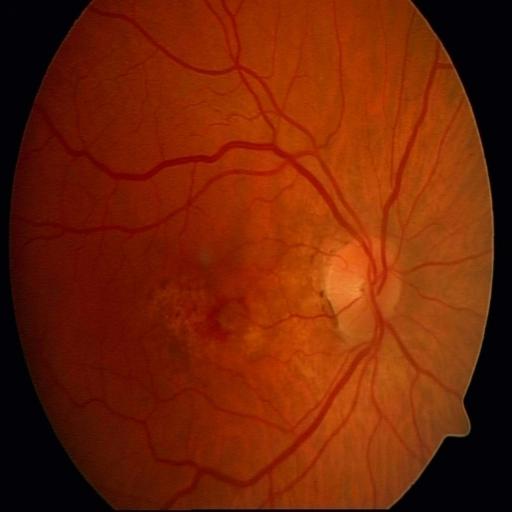 Impression:
- hemorrhagic retinopathy